640 by 480 pixels · wide-field fundus photograph of an infant · captured with the Clarity RetCam 3 (130° field of view) — 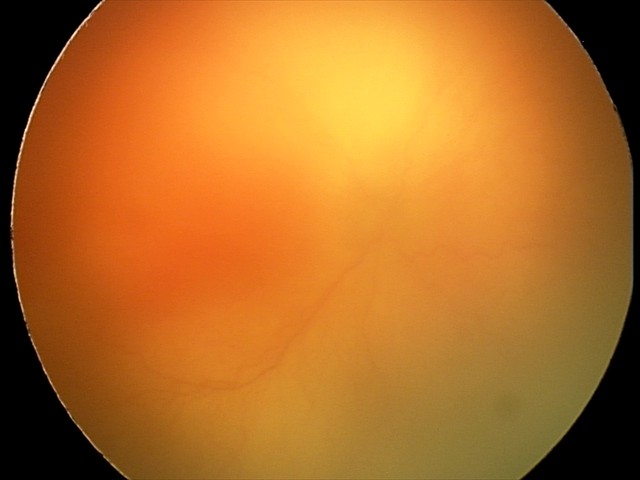

Examination diagnosed as aggressive retinopathy of prematurity.